Modified Davis grading · nonmydriatic · camera: NIDEK AFC-230.
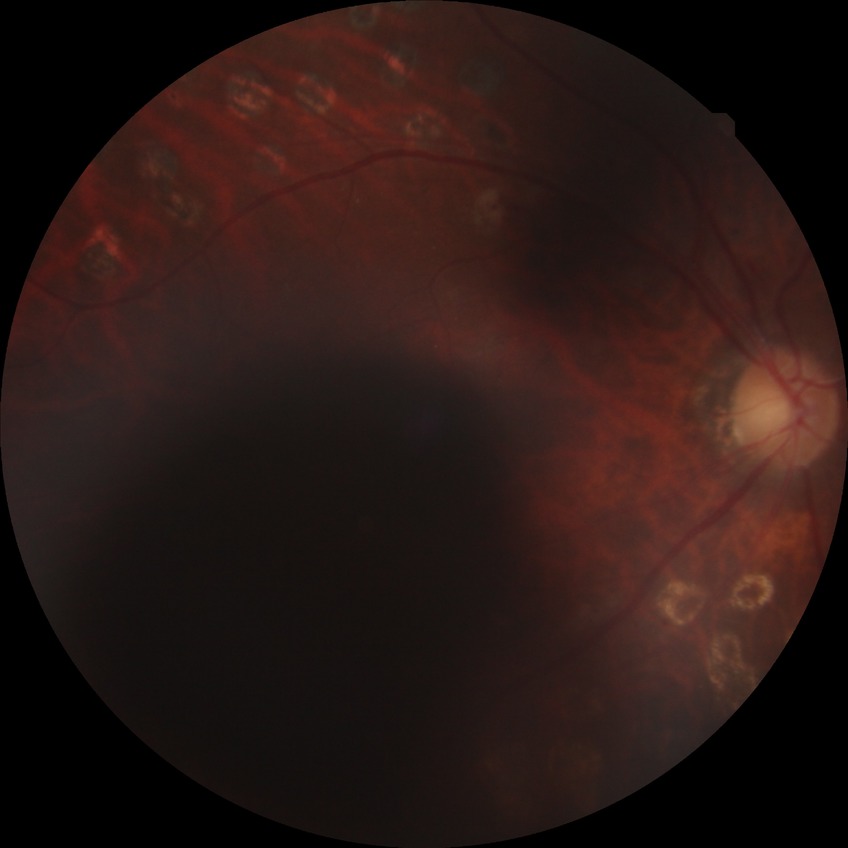

DR stage: PDR.